640 by 480 pixels · Clarity RetCam 3, 130° FOV · wide-field fundus image from infant ROP screening.
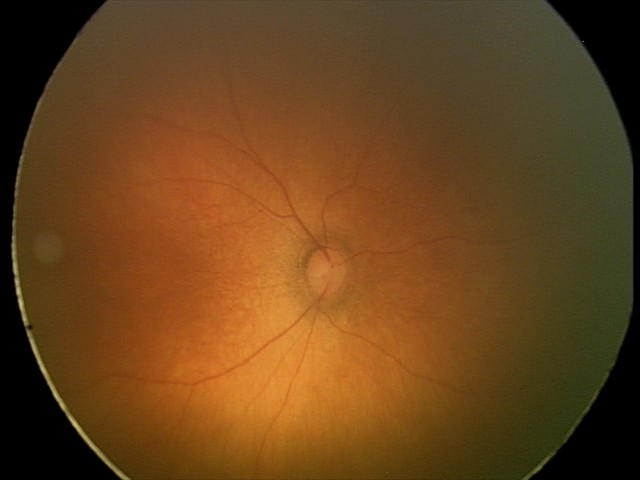
Impression = normal.